640x480 · RetCam wide-field infant fundus image: 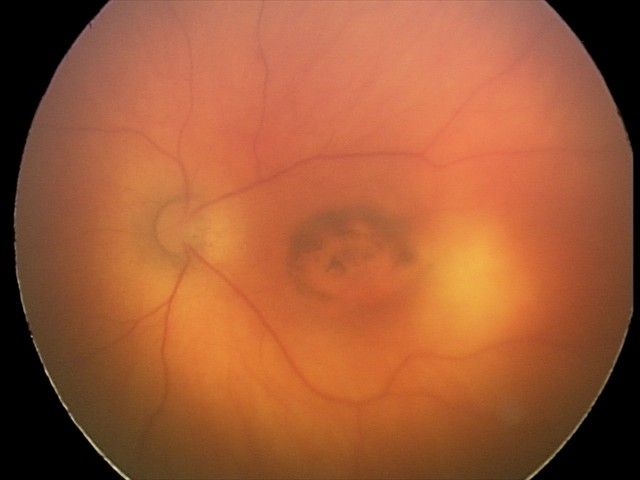

Assessment = toxoplasmosis chorioretinitis